Acquired with a Nidek AFC-330: 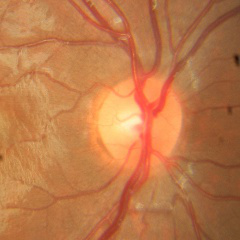
Findings consistent with no glaucoma.